640x480px · pediatric retinal photograph (wide-field):
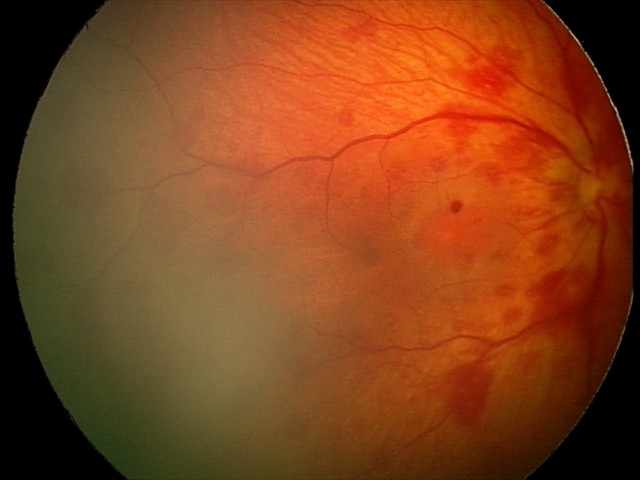

Q: What is the diagnosis from this examination?
A: retinal hemorrhages